Fundus photo. Acquired with a NIDEK AFC-230
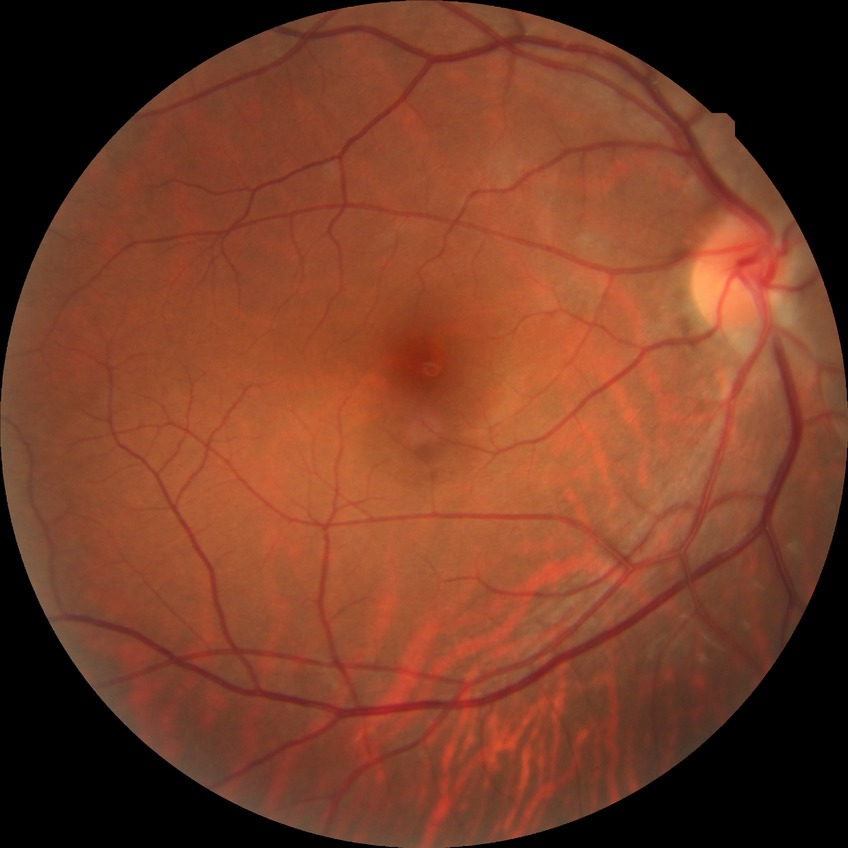 Diabetic retinopathy (DR) is no diabetic retinopathy (NDR).